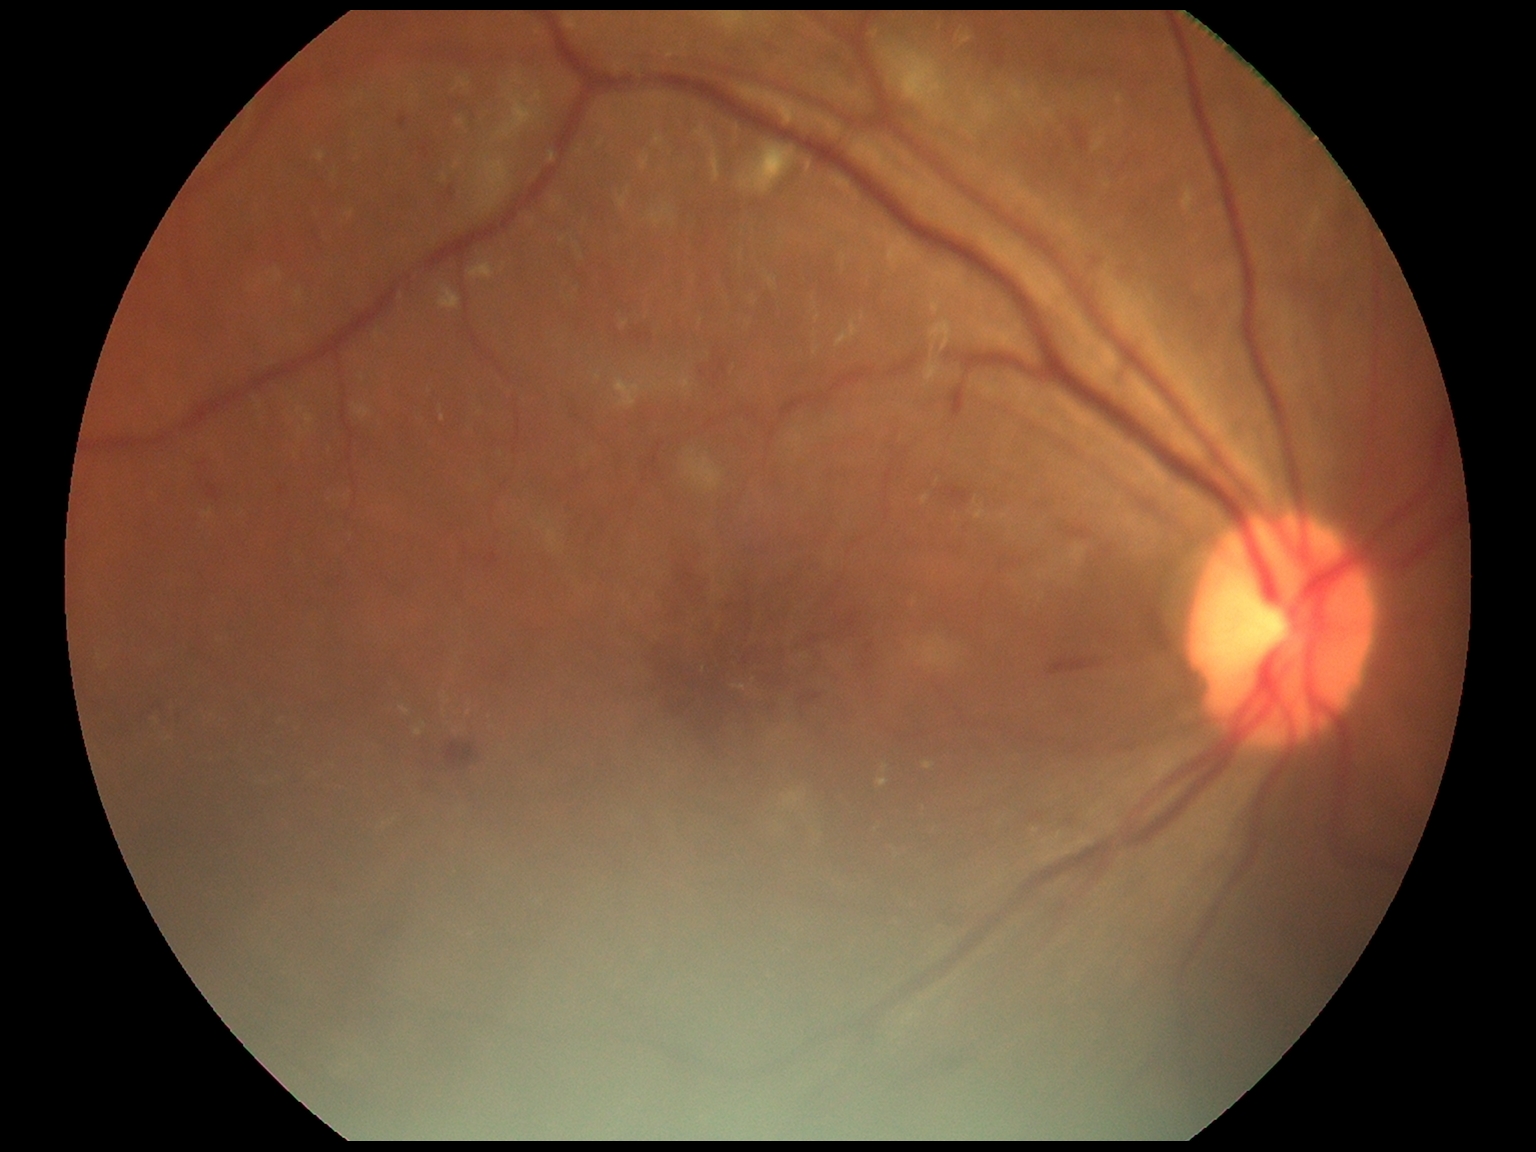 The retinopathy is classified as non-proliferative diabetic retinopathy.
Diabetic retinopathy grade: moderate non-proliferative diabetic retinopathy (2).